Retinal fundus photograph
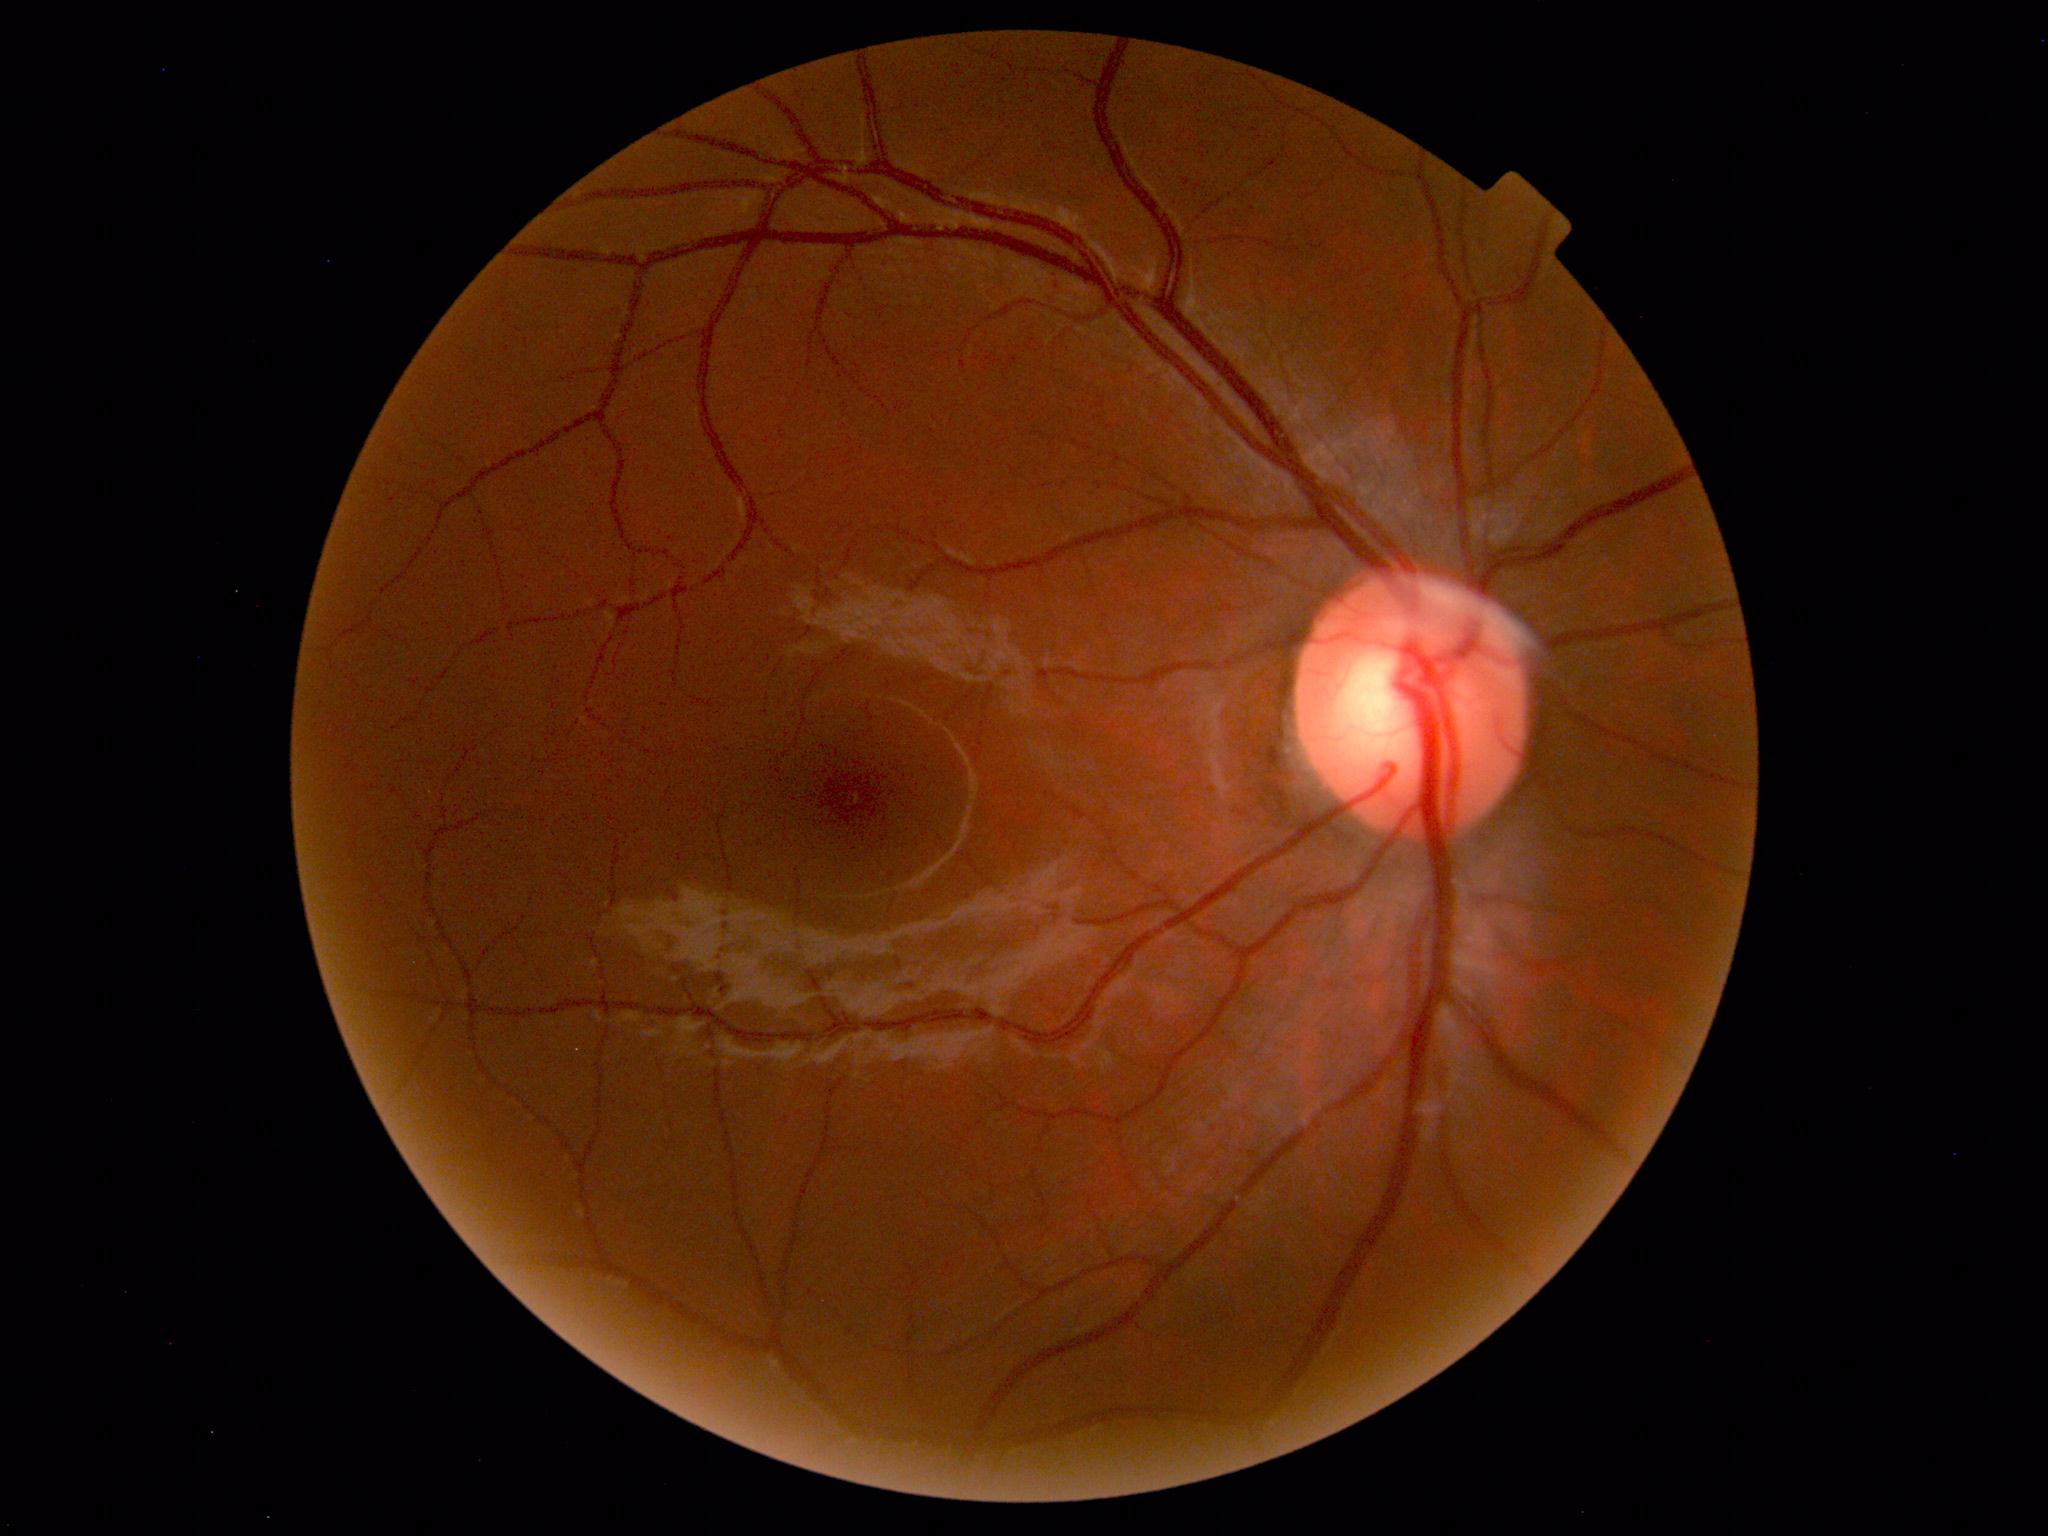
Findings: no abnormalities.